RetCam wide-field infant fundus image. 640 by 480 pixels
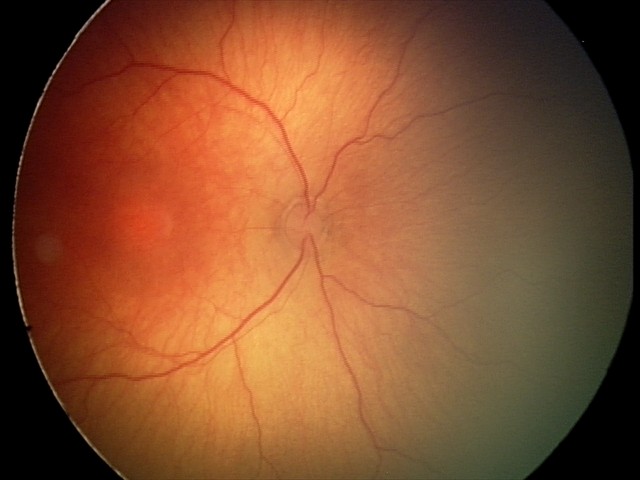

Diagnosis from this screening exam: retinopathy of prematurity (ROP) stage 2.